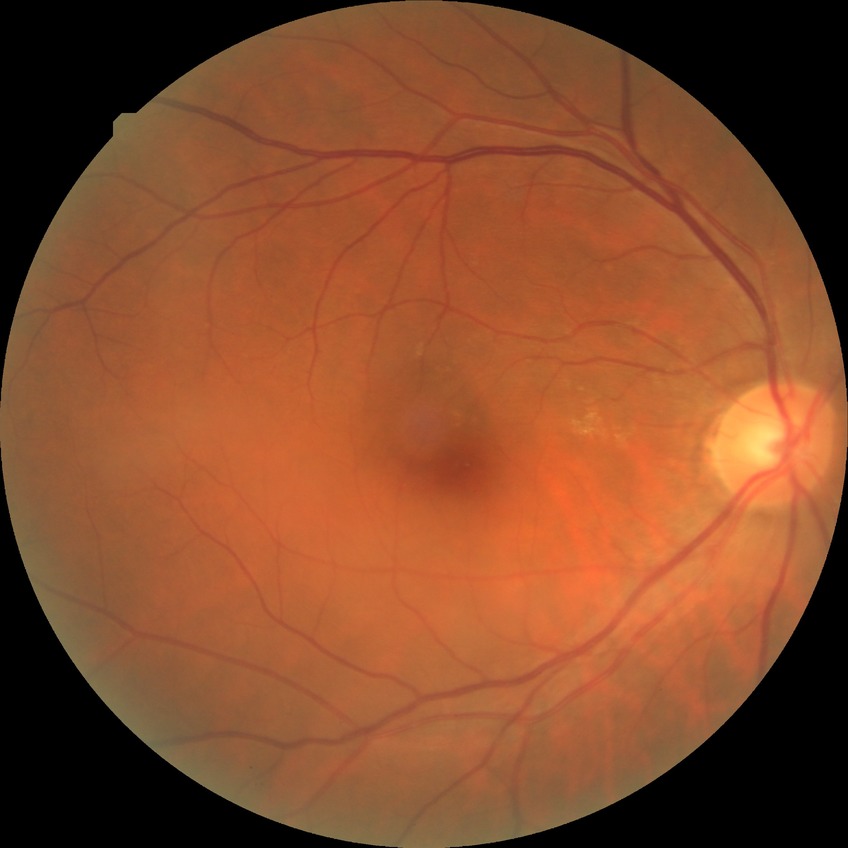

Diabetic retinopathy (DR): NDR (no diabetic retinopathy).